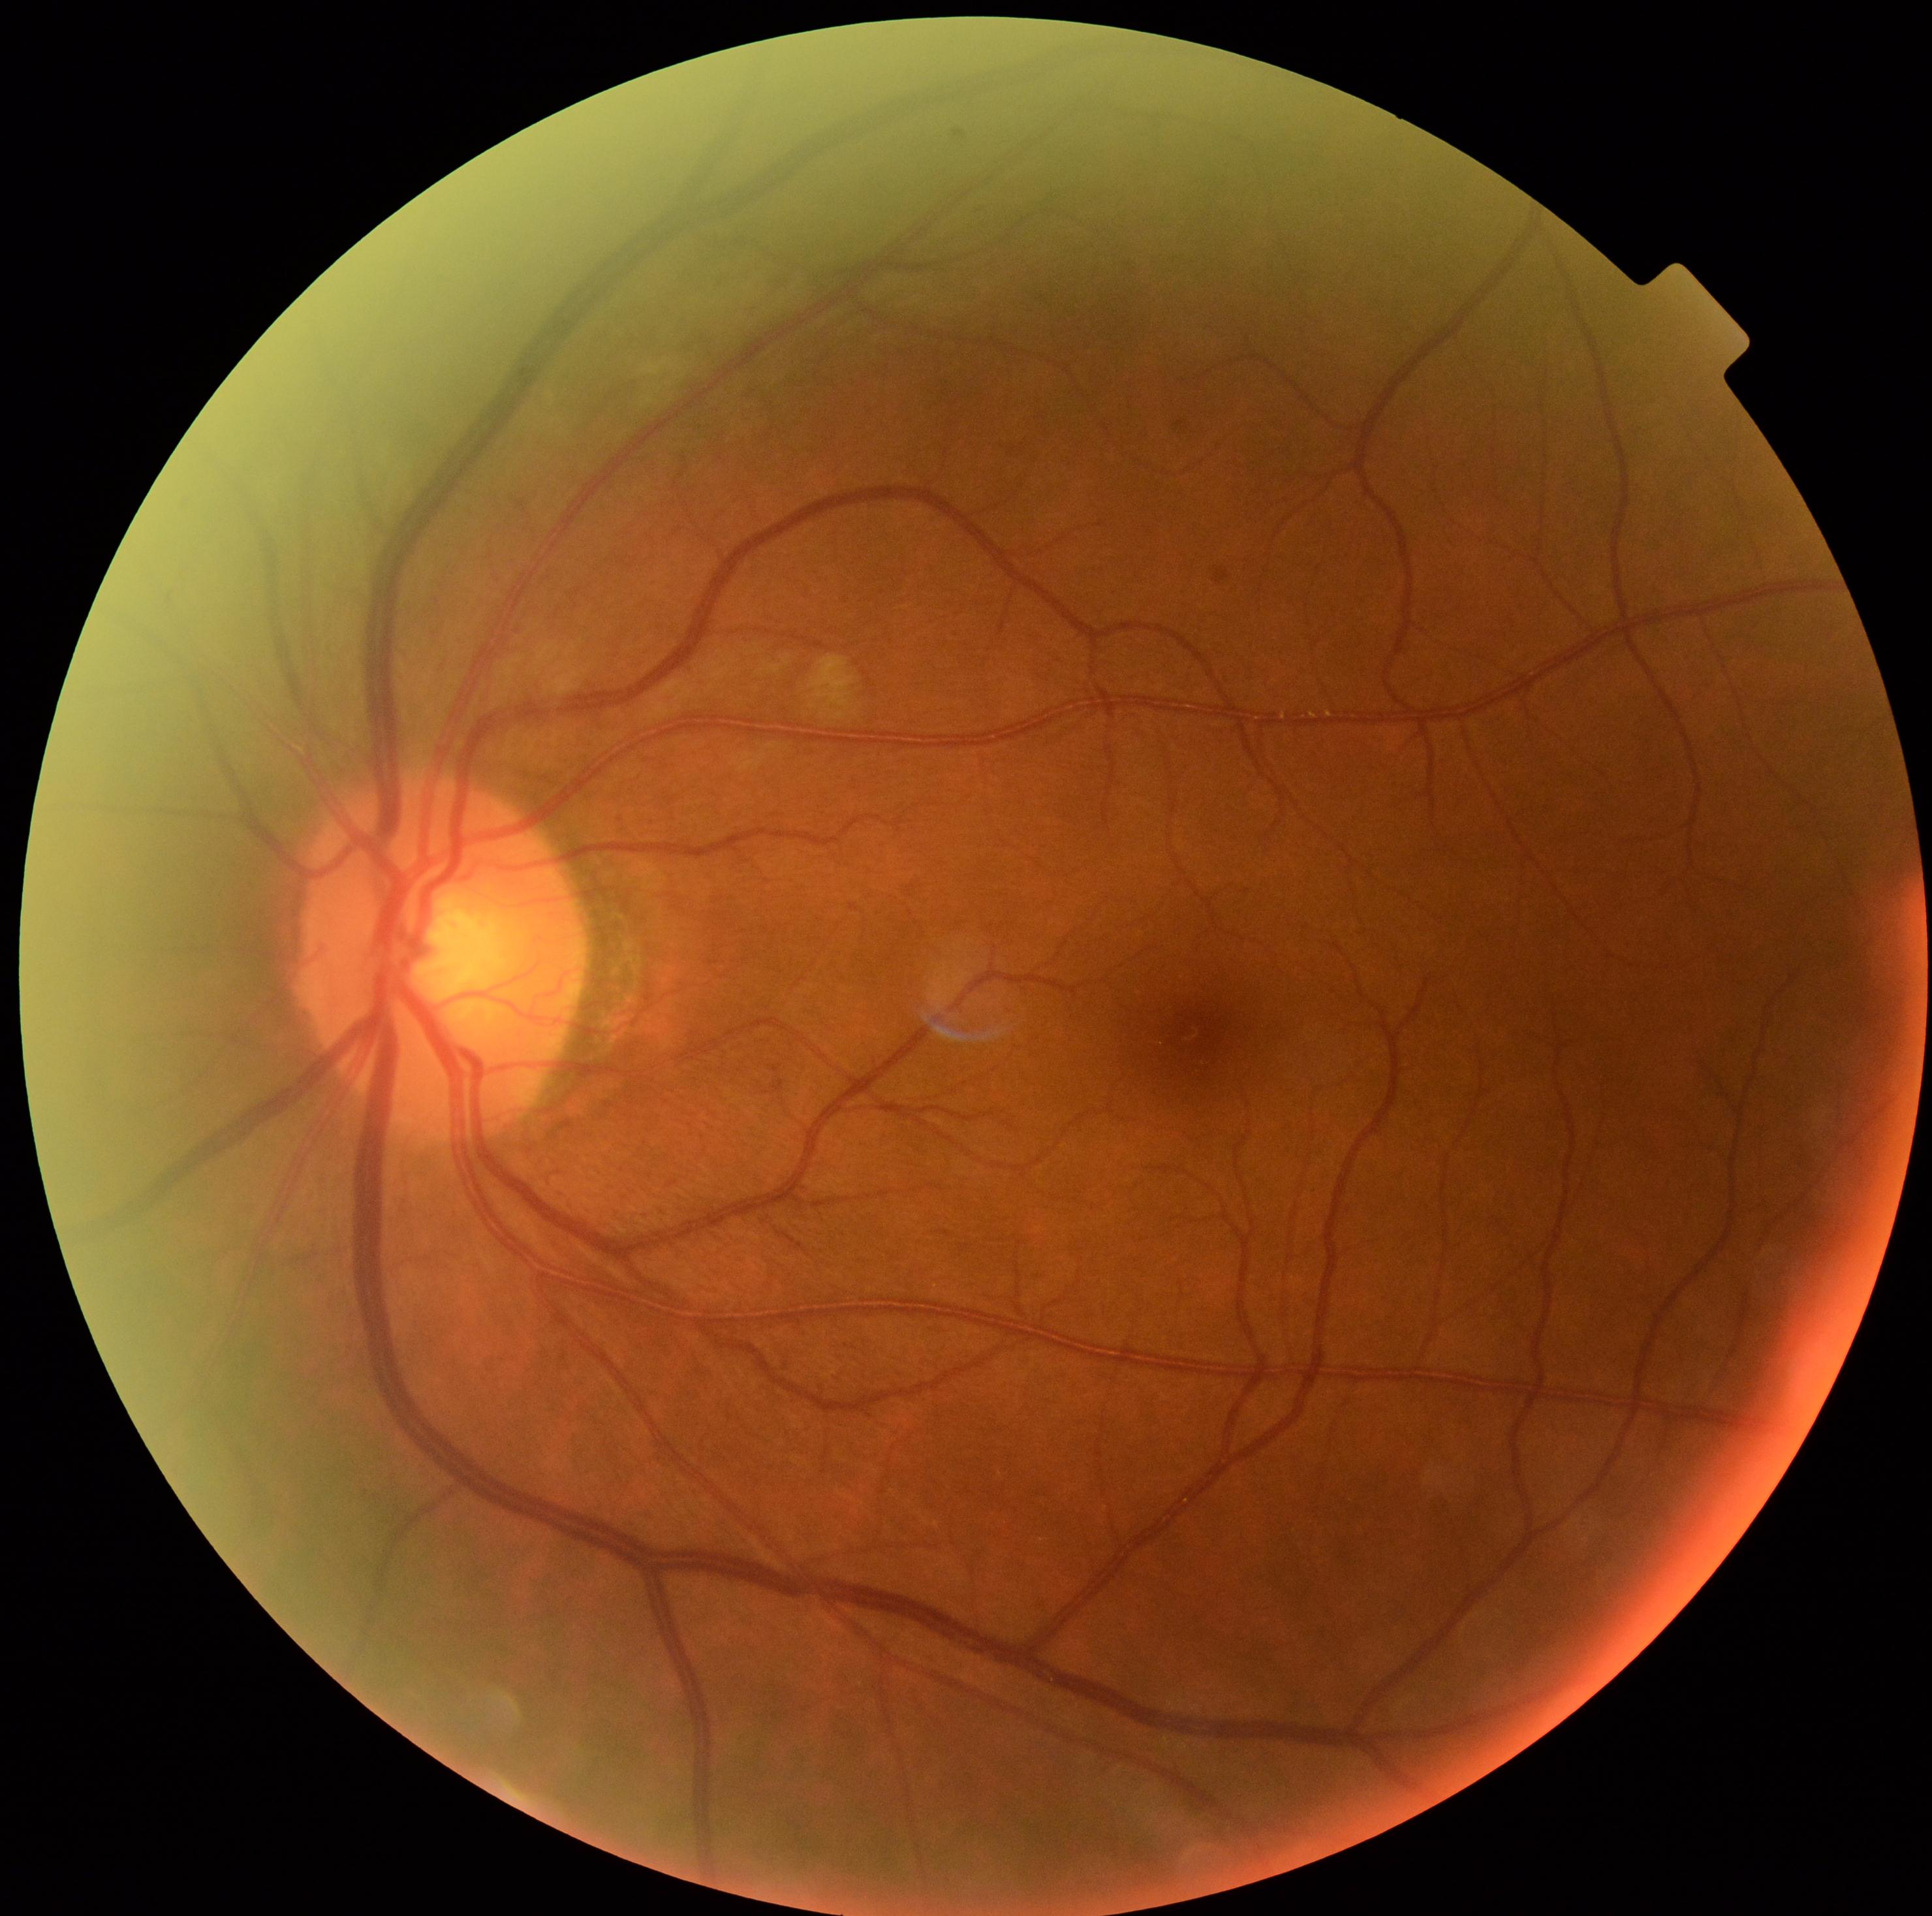

Retinopathy grade is 2 (moderate NPDR).